Acquired with a NIDEK AFC-230, FOV: 45 degrees.
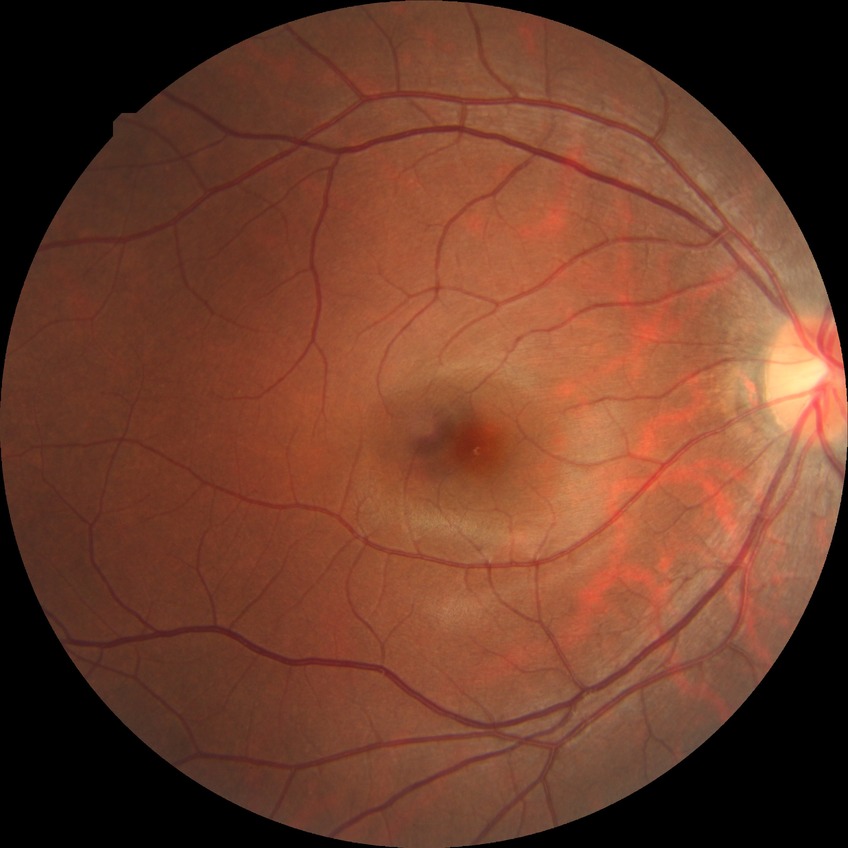
Diabetic retinopathy grade is no diabetic retinopathy.